Nonmydriatic; FOV: 45 degrees:
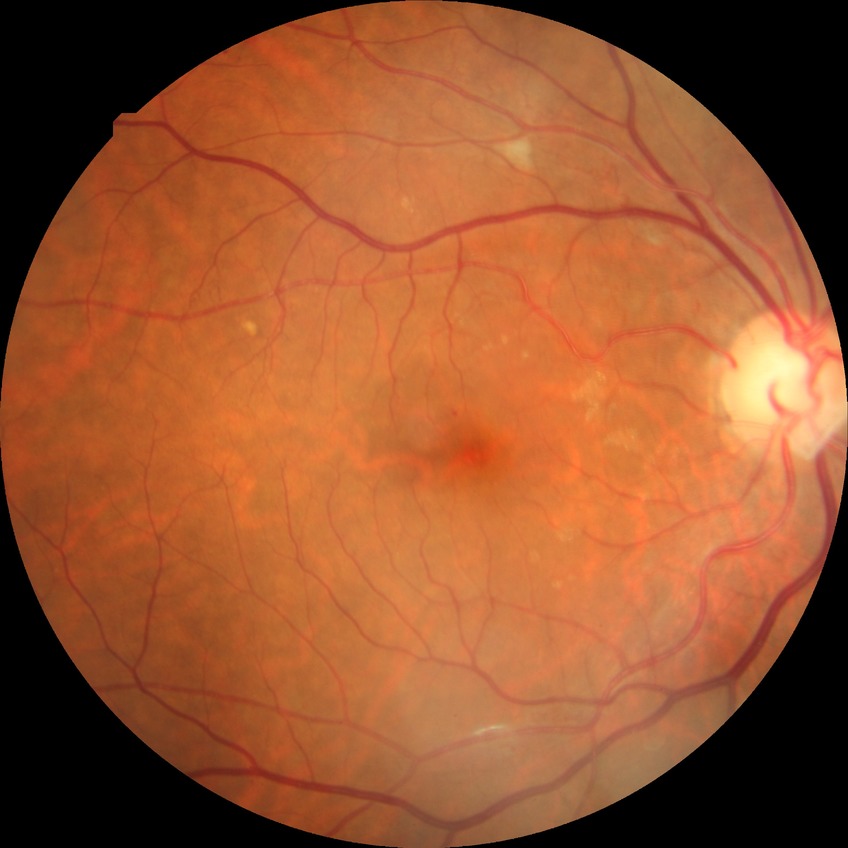 Diabetic retinopathy (DR): pre-proliferative diabetic retinopathy (PPDR).